Infant wide-field retinal image — 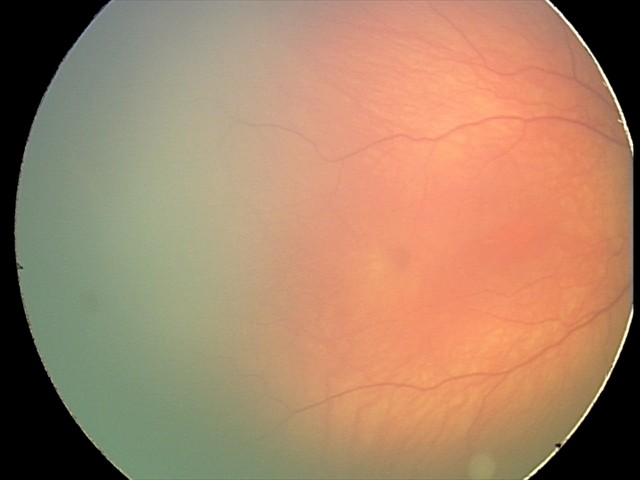

No plus disease. Screening examination consistent with status post retinopathy of prematurity — retinal appearance after treated retinopathy of prematurity.